45-degree field of view; image size 2212x1672 — 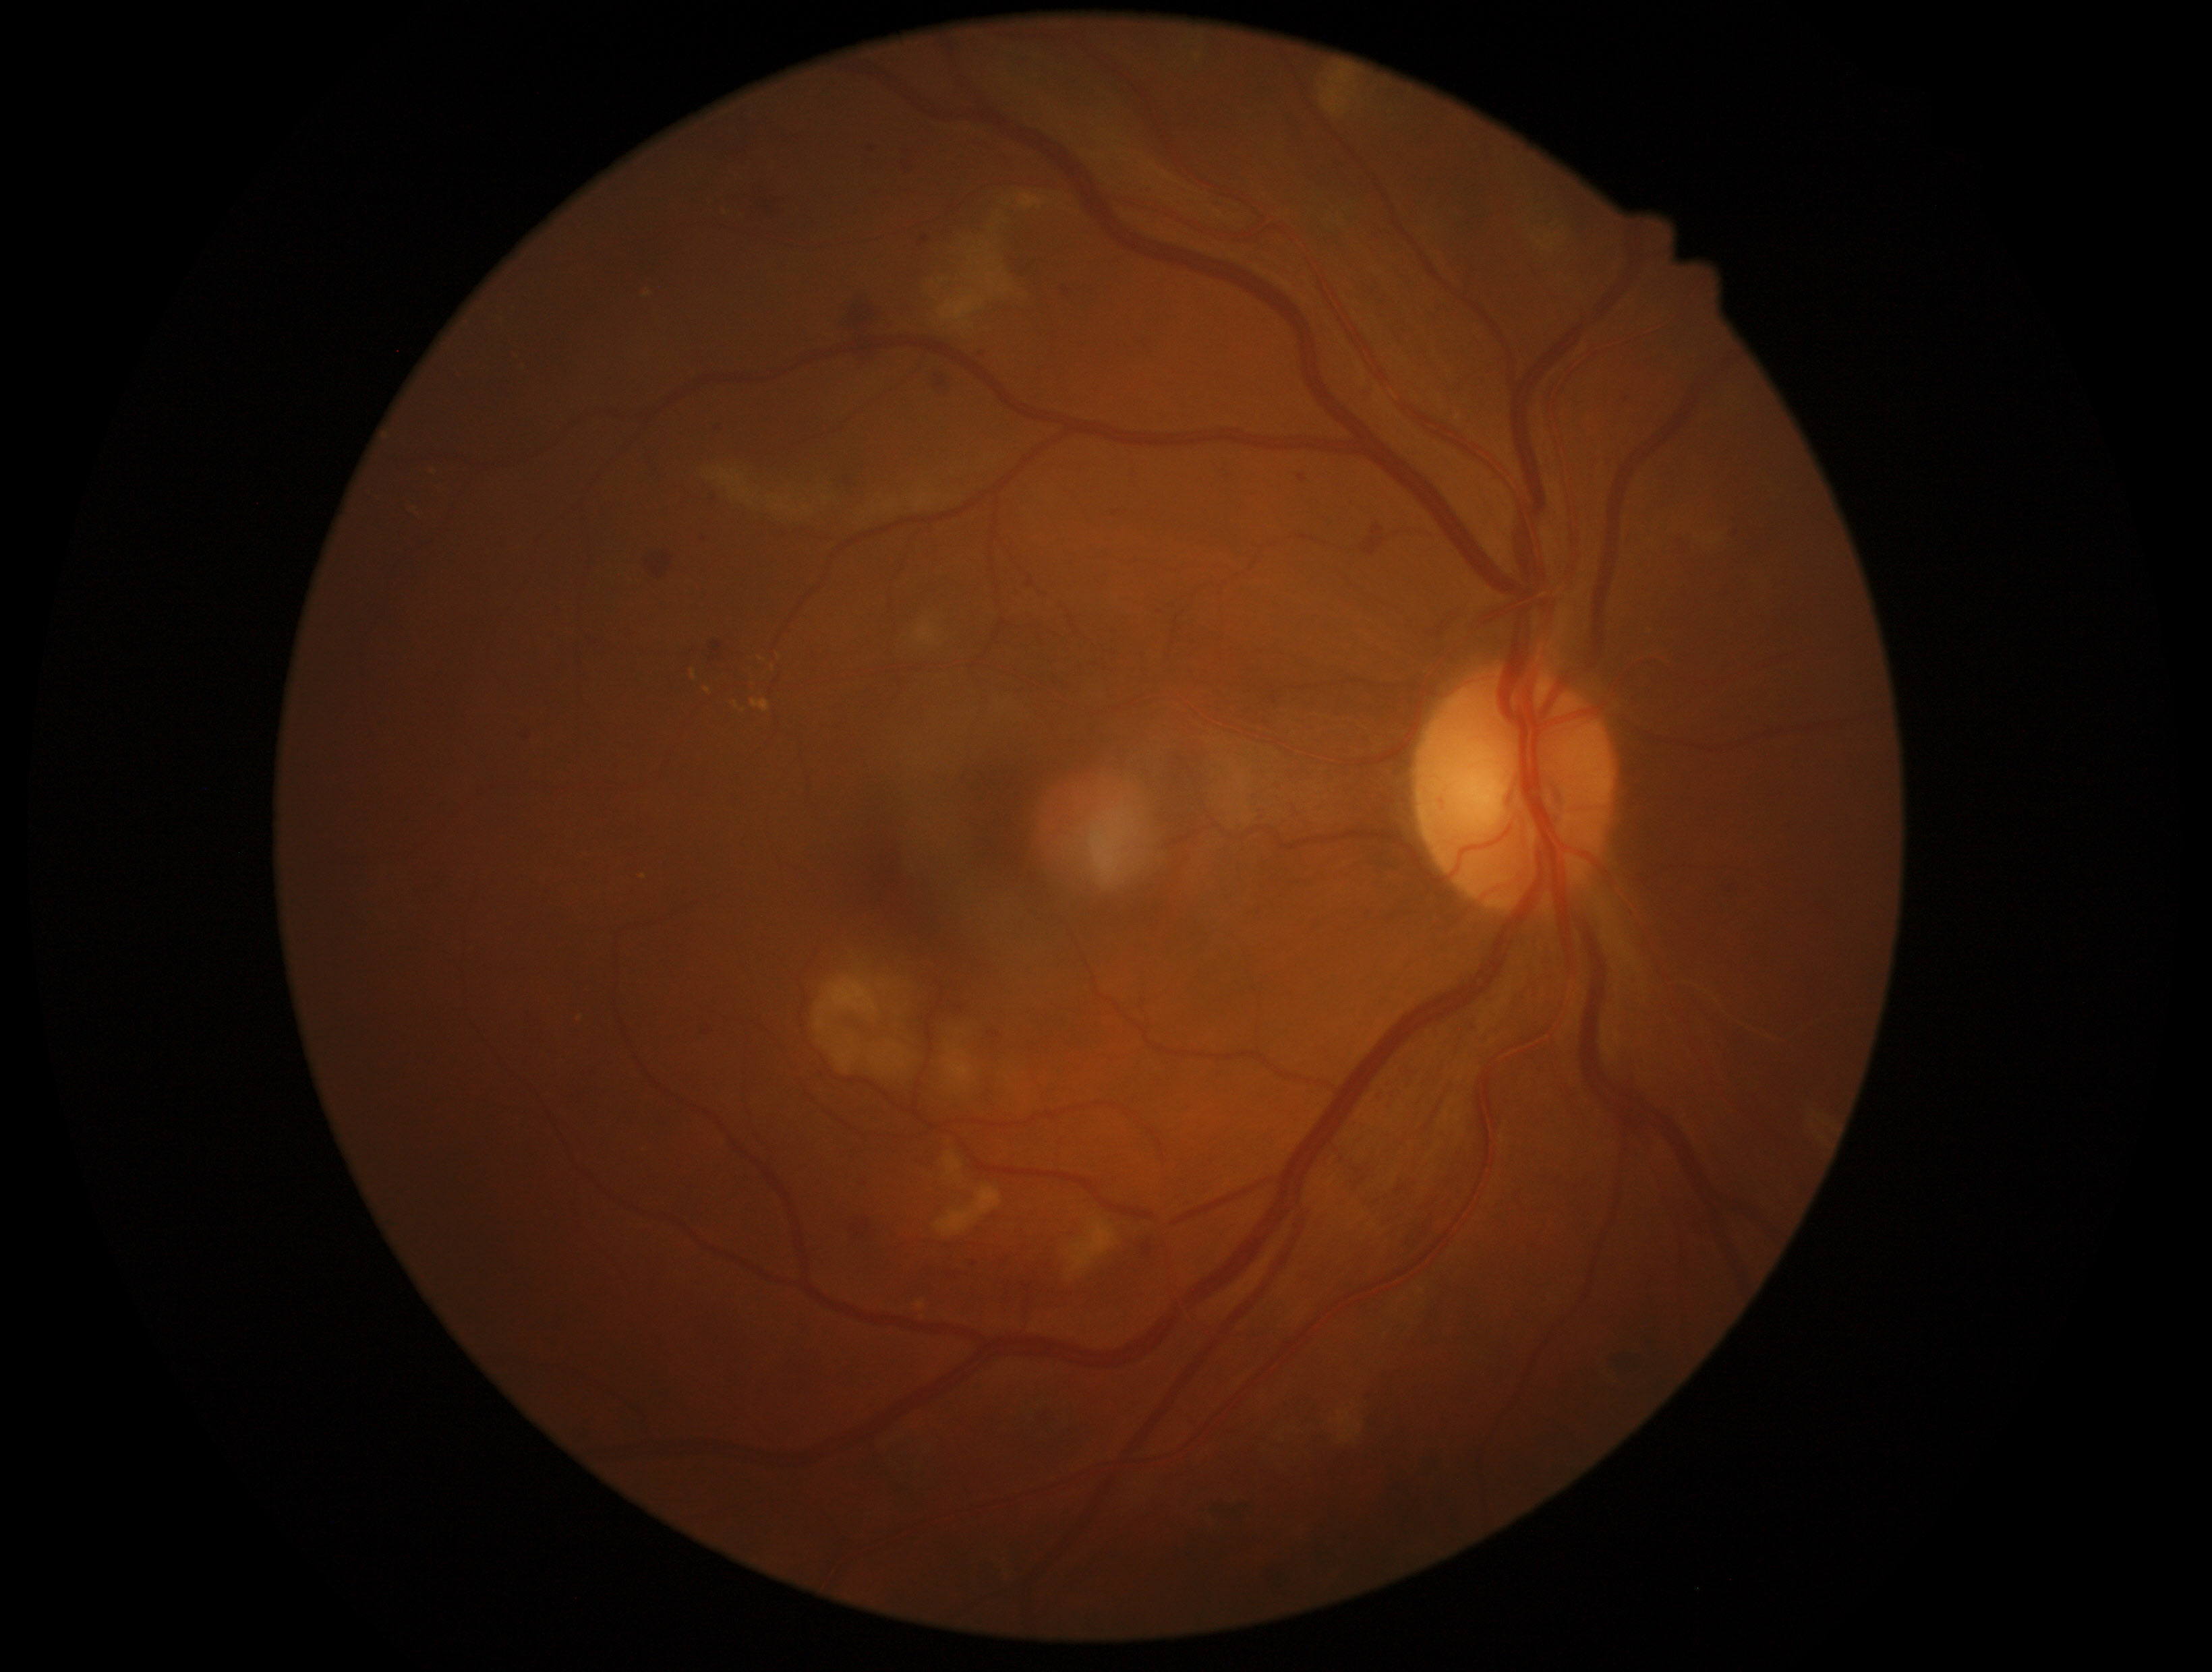 DR stage@2/4.